Davis DR grading.
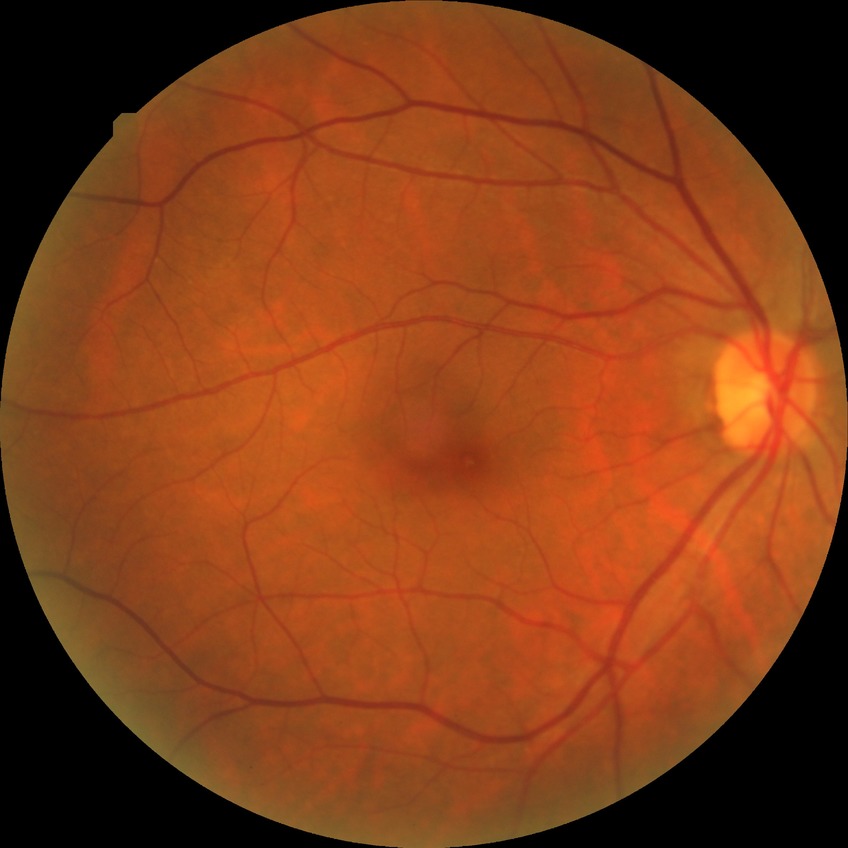 Diabetic retinopathy (DR) is NDR (no diabetic retinopathy).